Pupil-dilated. Macula-centered.
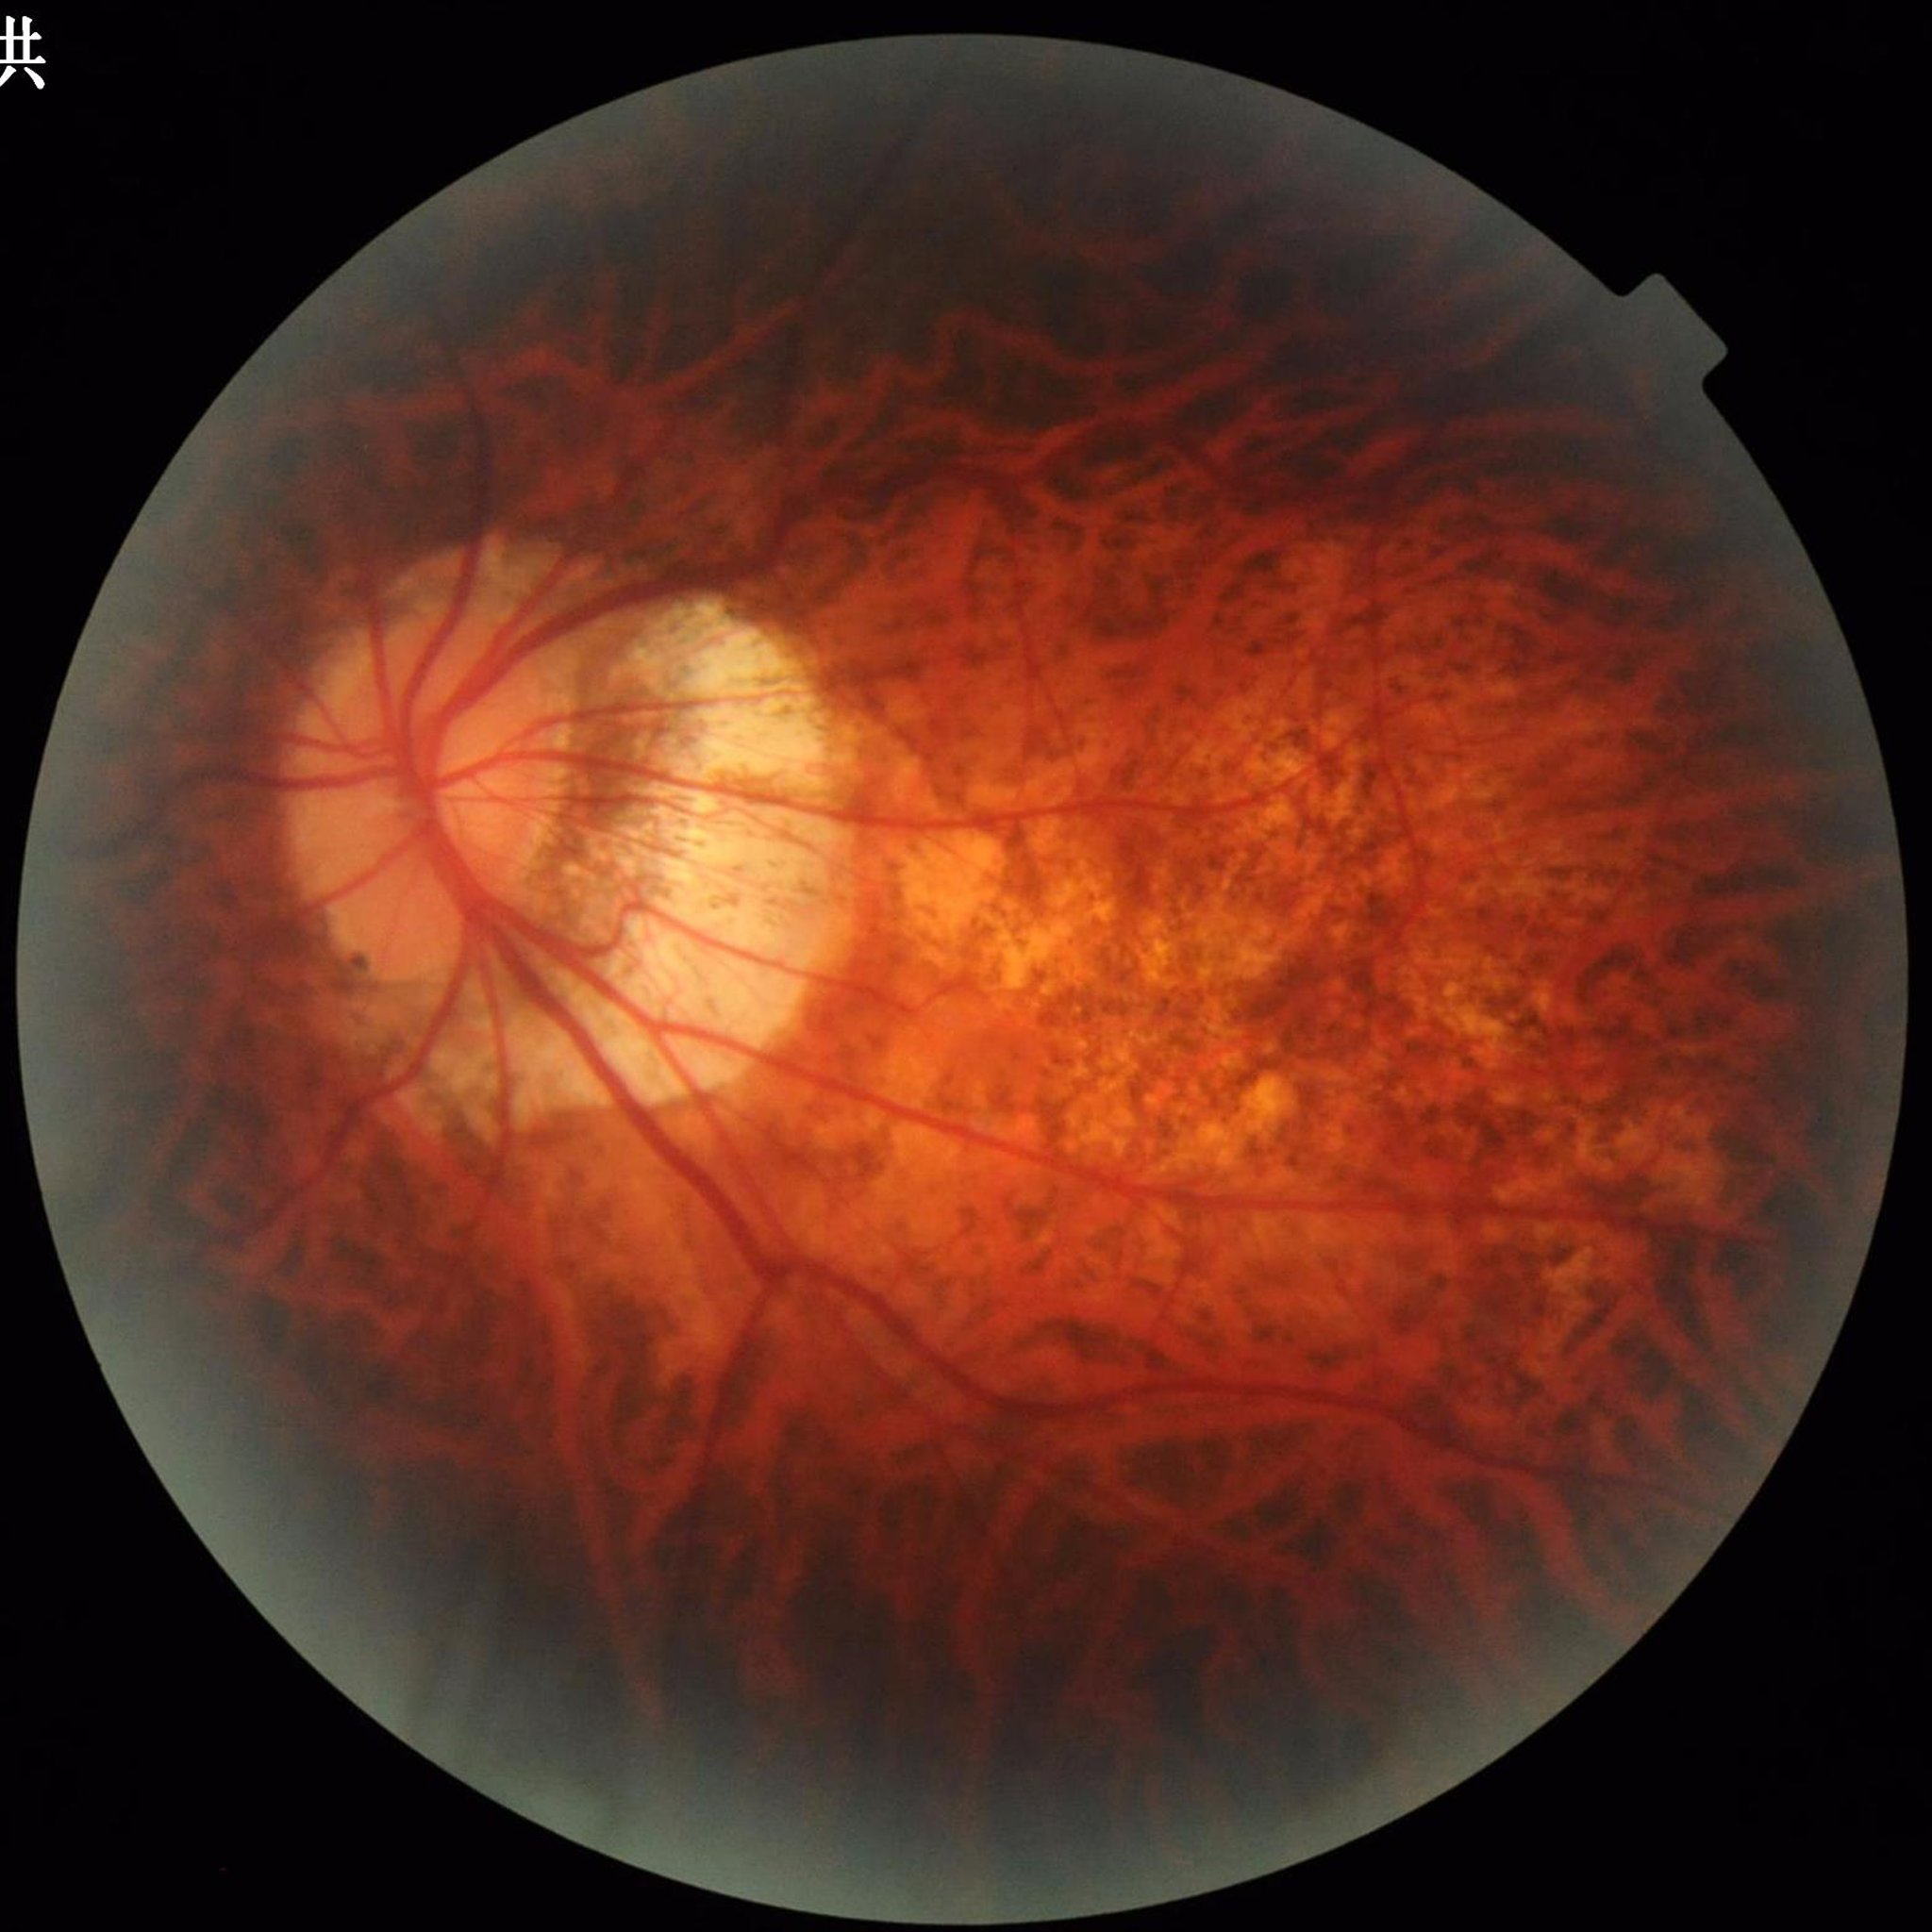

Color fundus photo. Patient diagnosed with glaucoma. Photo quality: issues noted — illumination/color distortion.